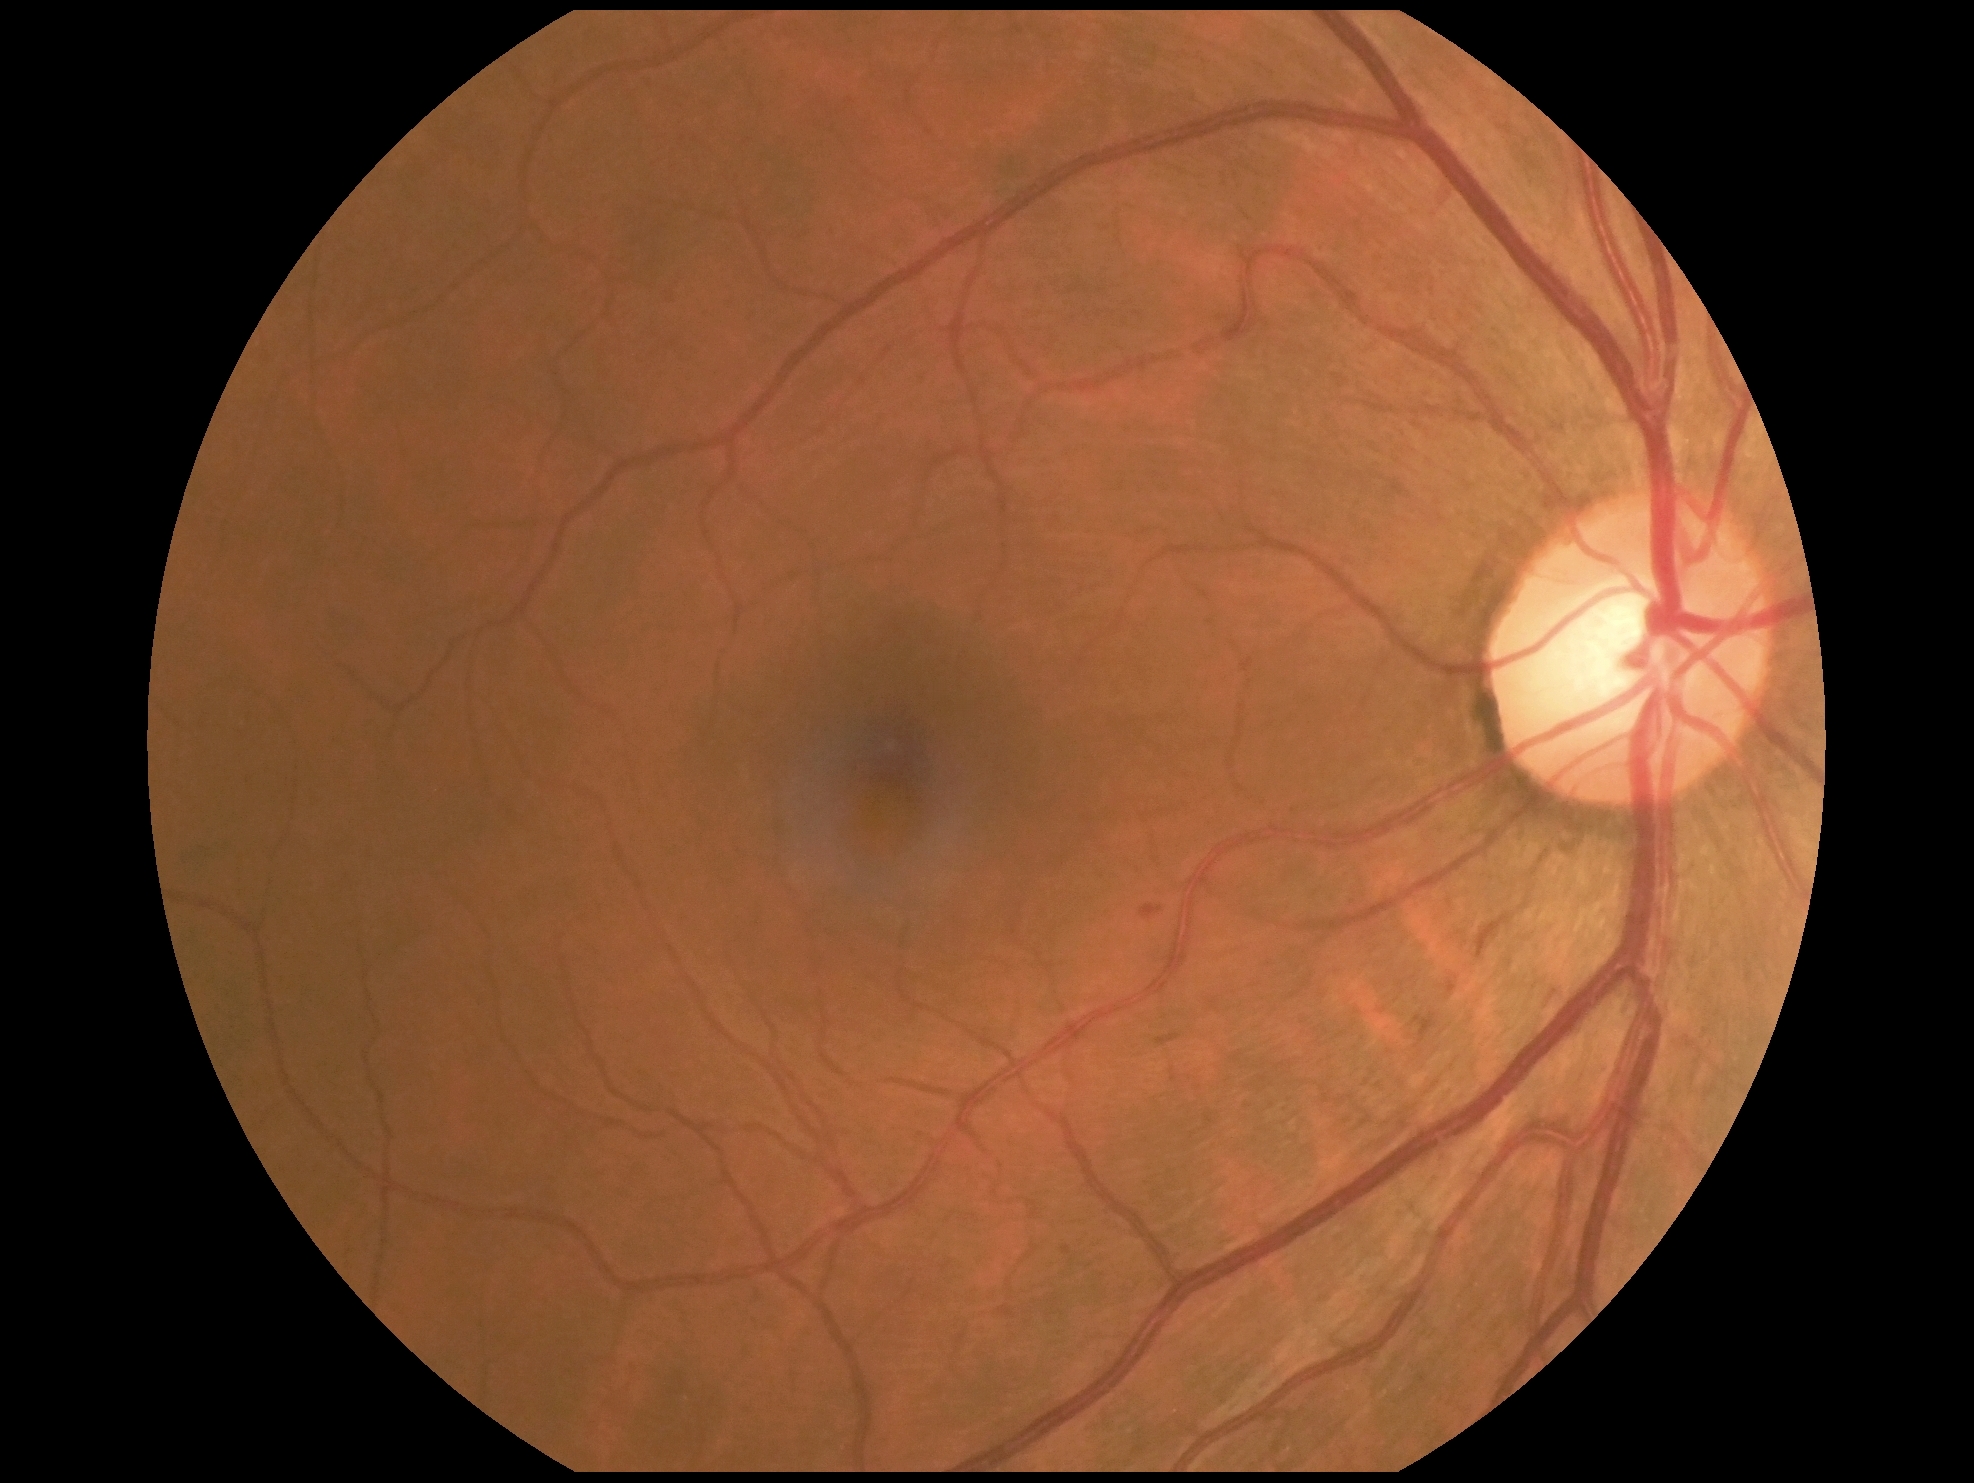
* DR class — non-proliferative diabetic retinopathy
* DR — grade 2 (moderate NPDR) — more than just microaneurysms but less than severe NPDR